Fundus image cropped to the optic disc:
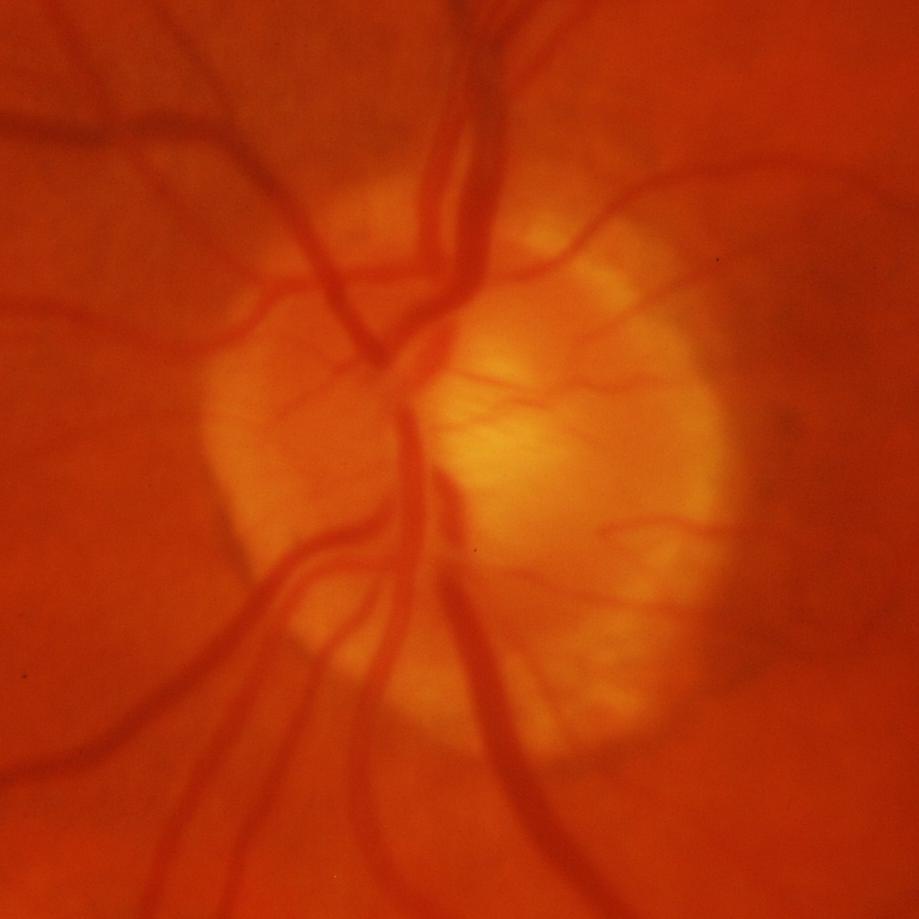
The image shows glaucomatous damage to the optic nerve.